CFP. 1659 x 2212 pixels: 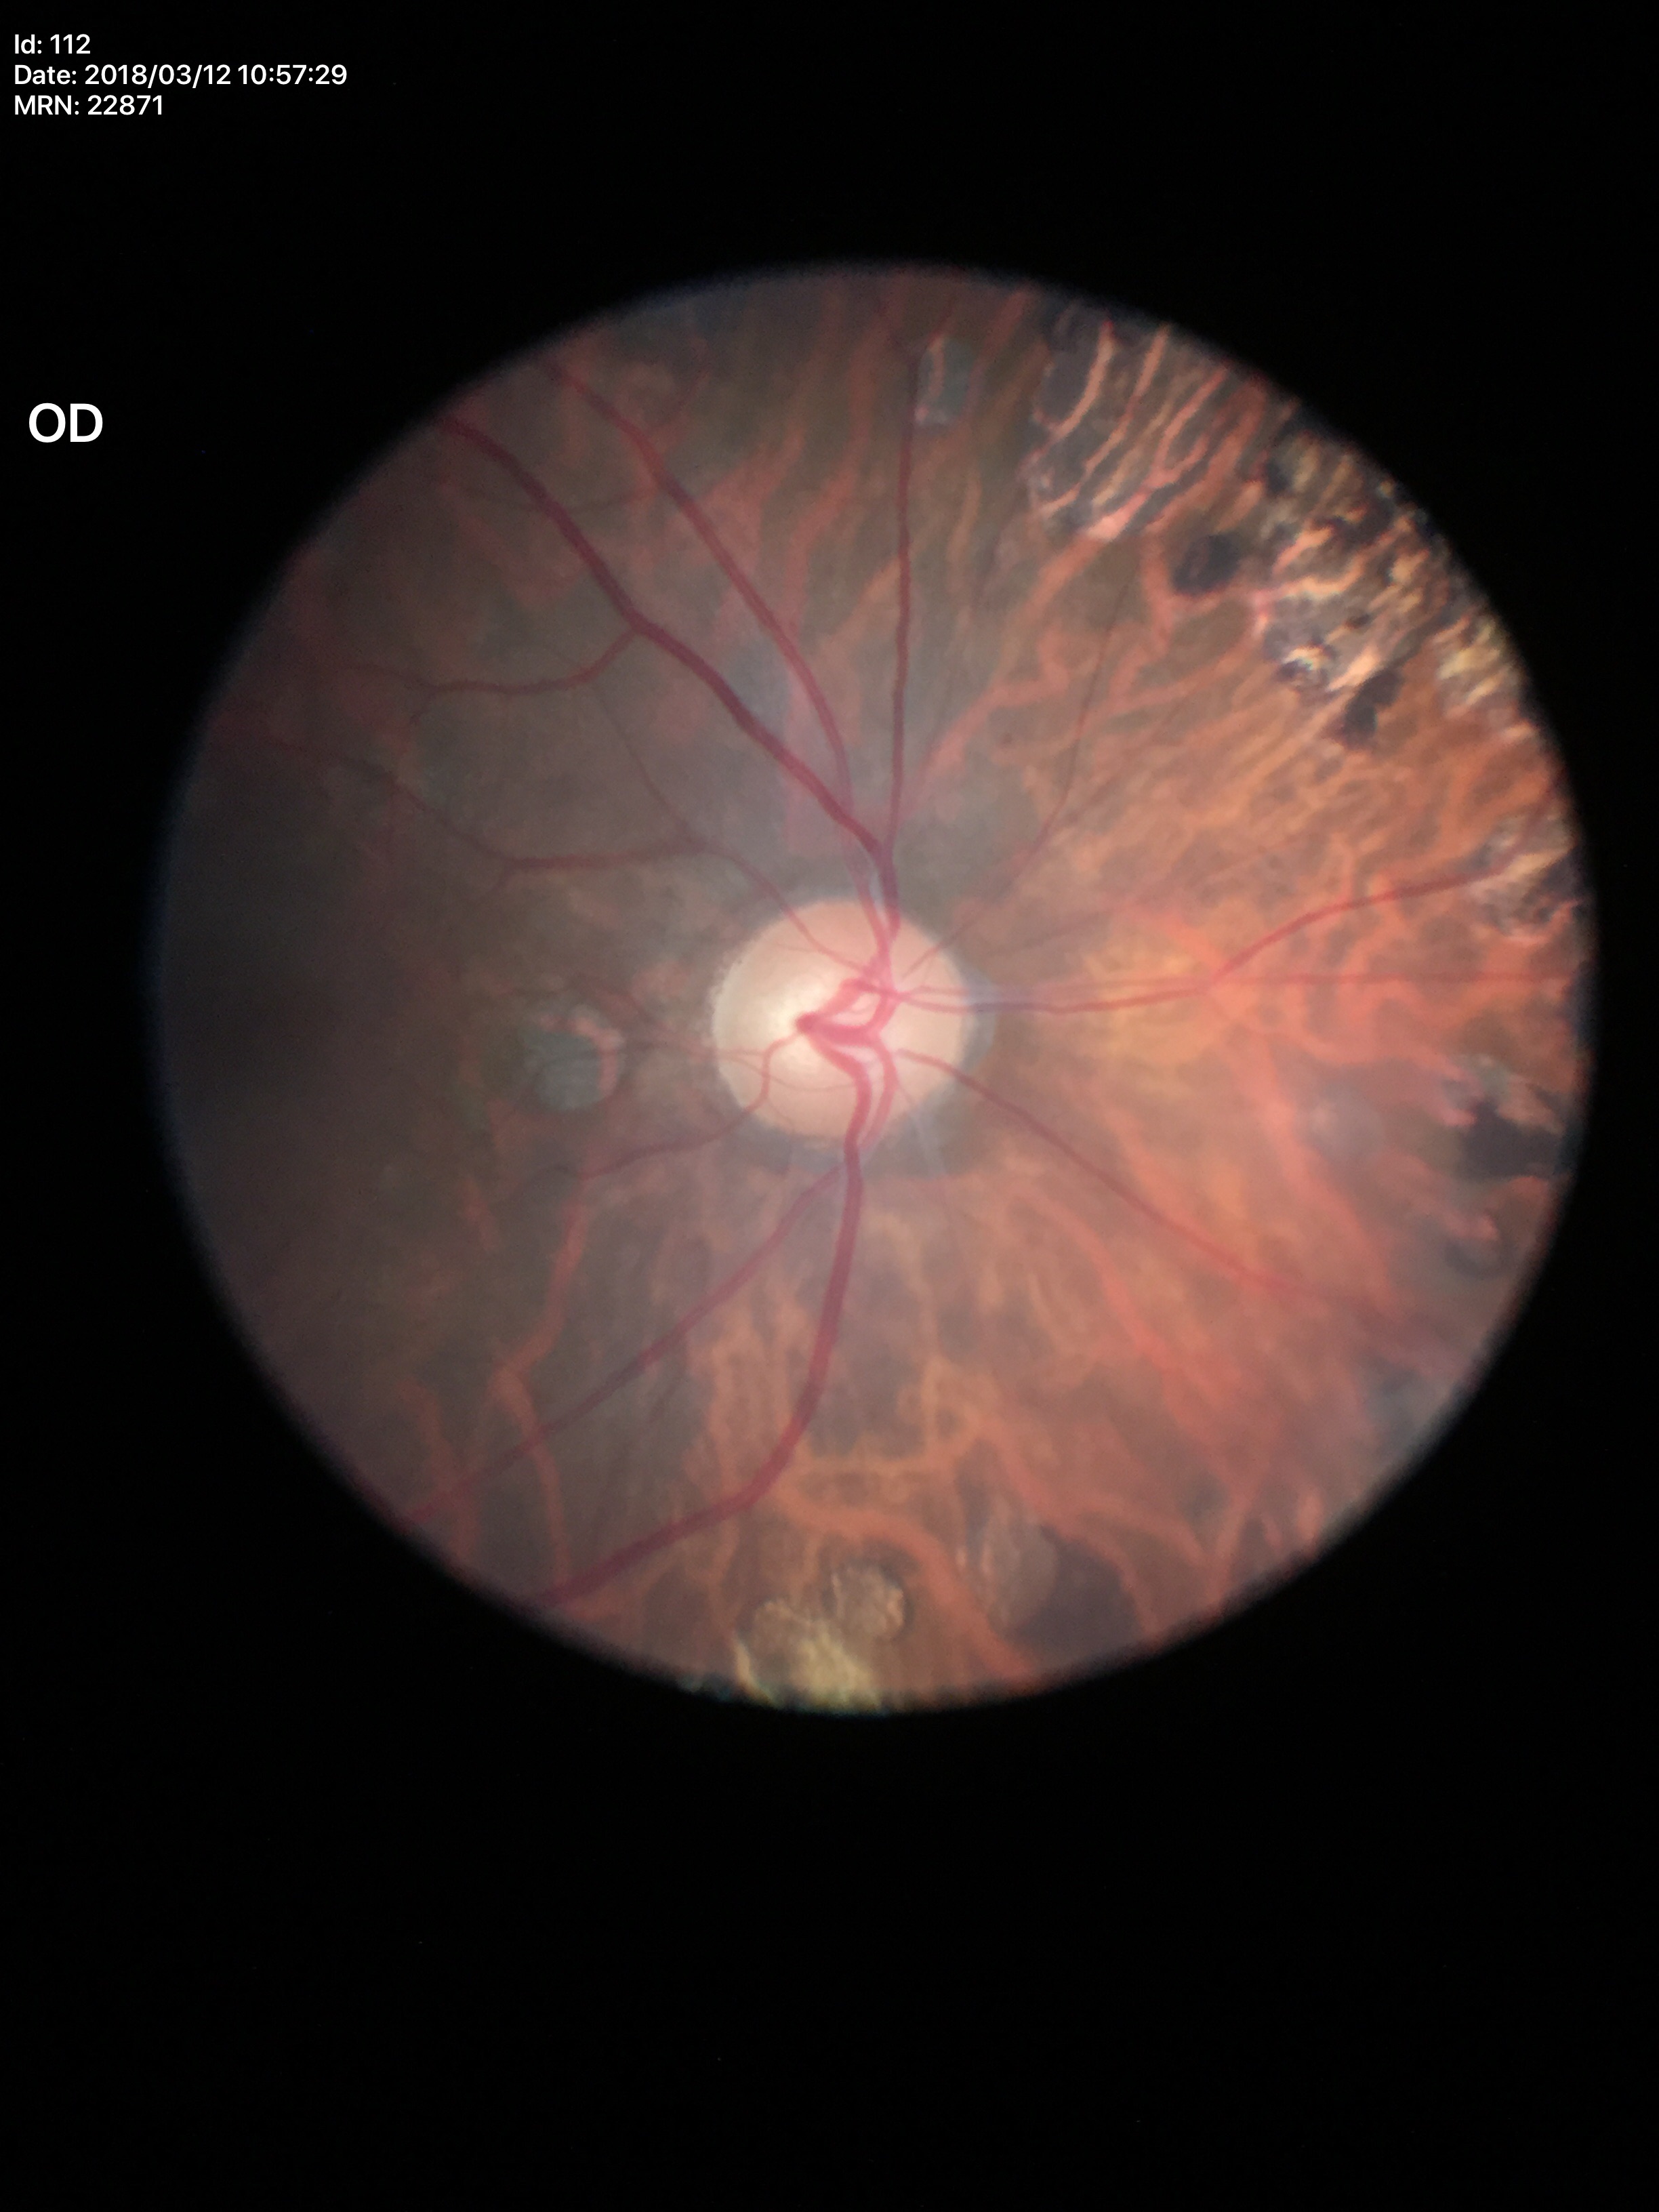

Glaucoma impression: no suspicious findings | vertical C/D ratio: 0.52.